848 x 848 pixels: 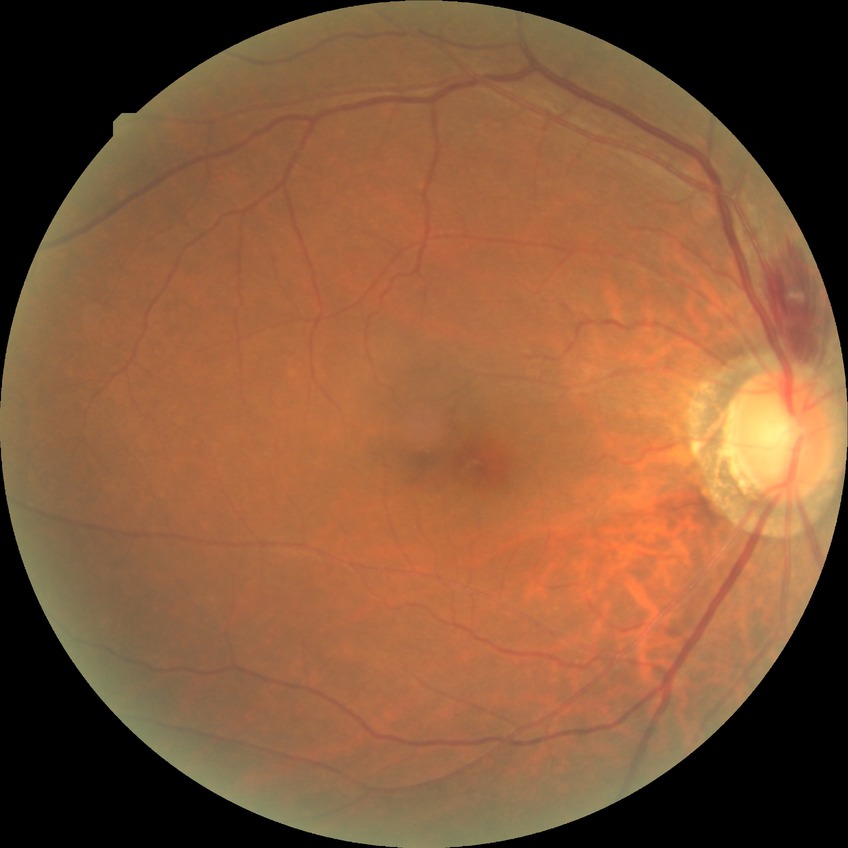

modified Davis classification: simple diabetic retinopathy.